NIDEK AFC-230 fundus camera. Color fundus photograph. DR severity per modified Davis staging
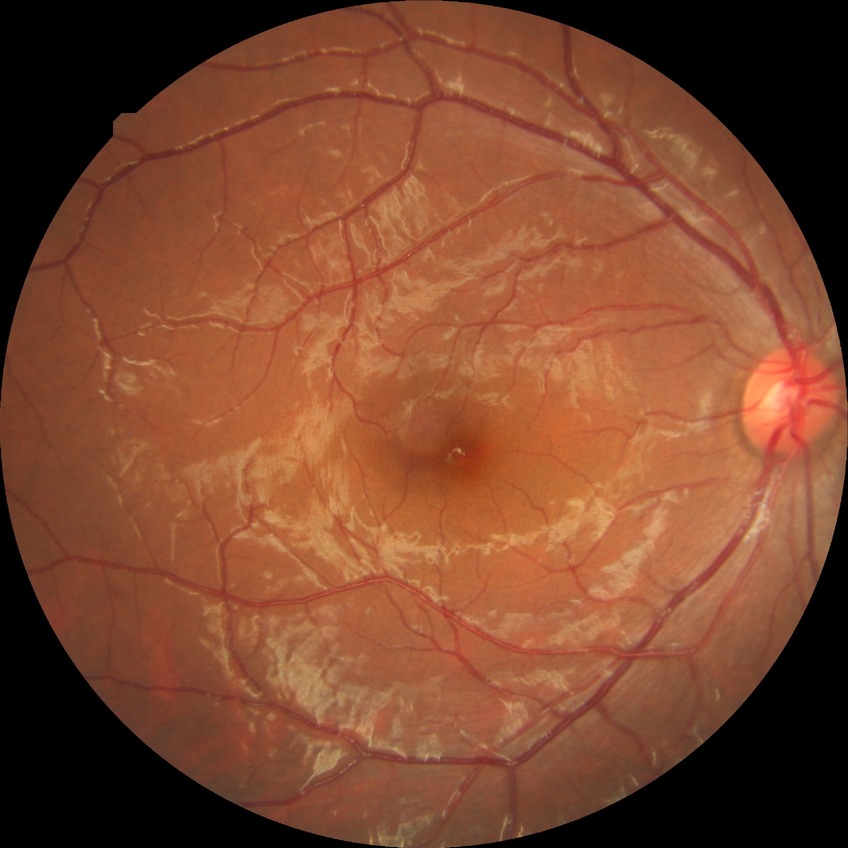
diabetic retinopathy (DR): simple diabetic retinopathy (SDR)